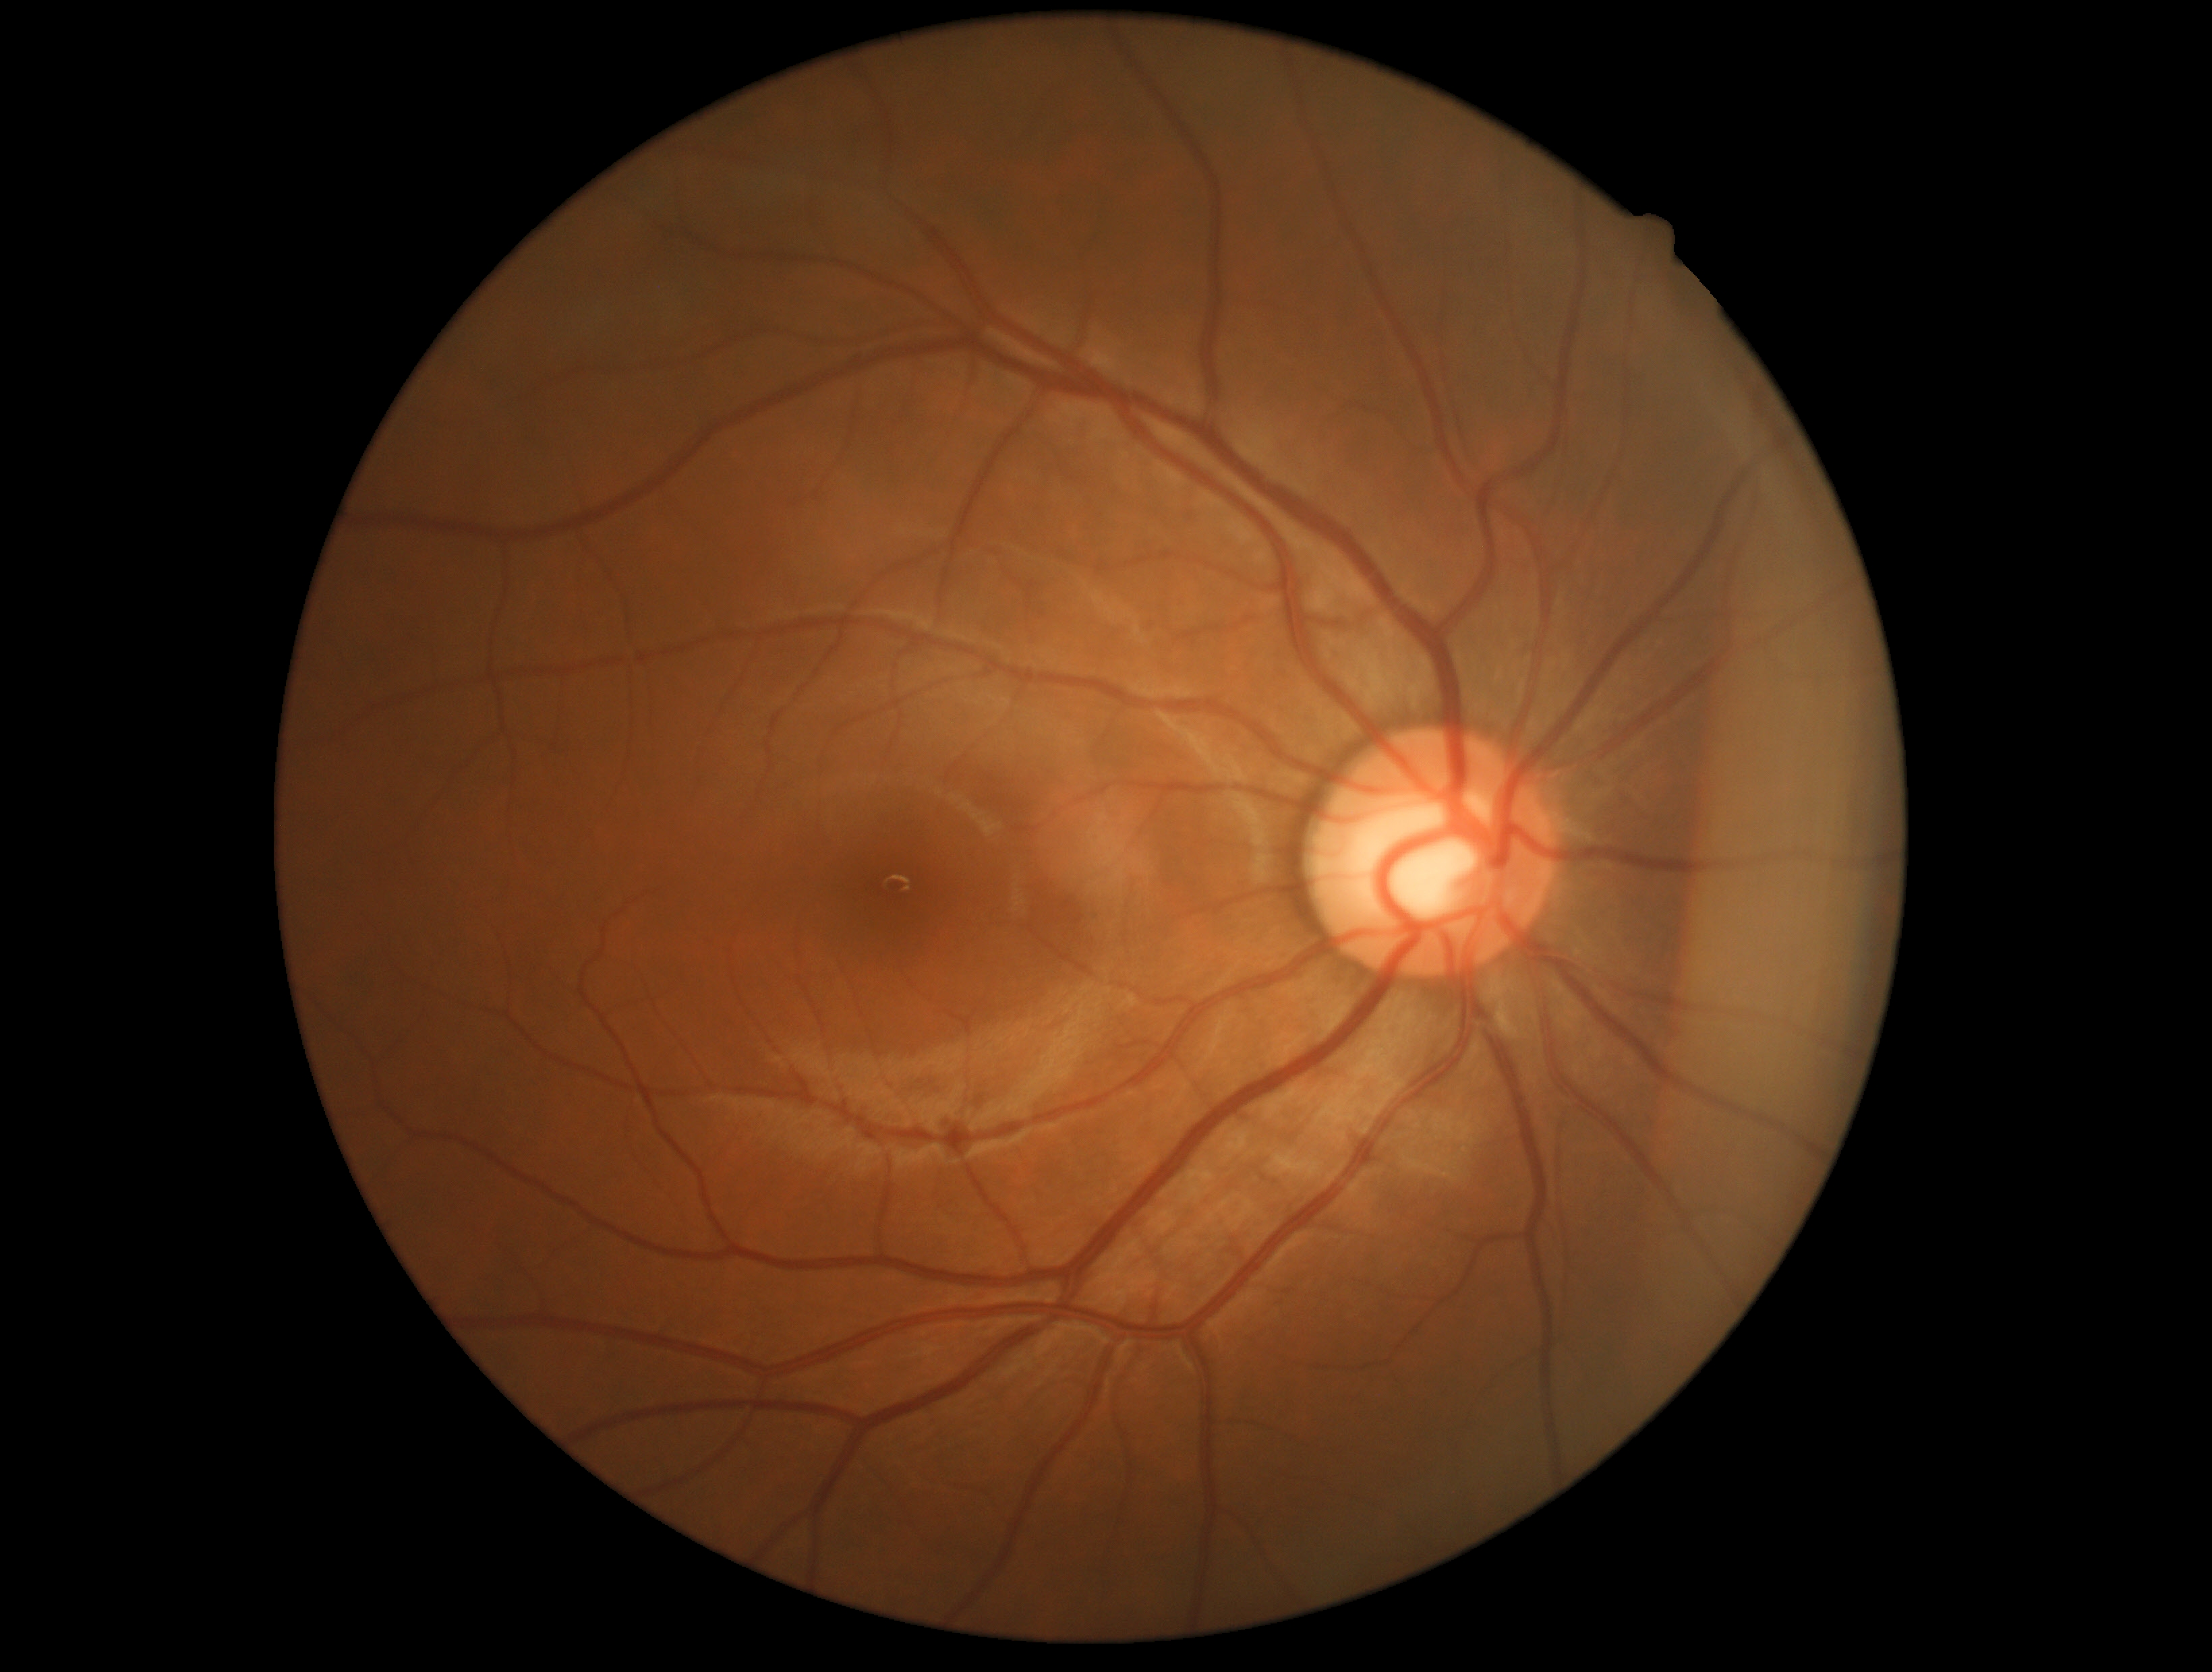 No apparent diabetic retinopathy.
Retinopathy: grade 0 (no apparent retinopathy).